45-degree field of view:
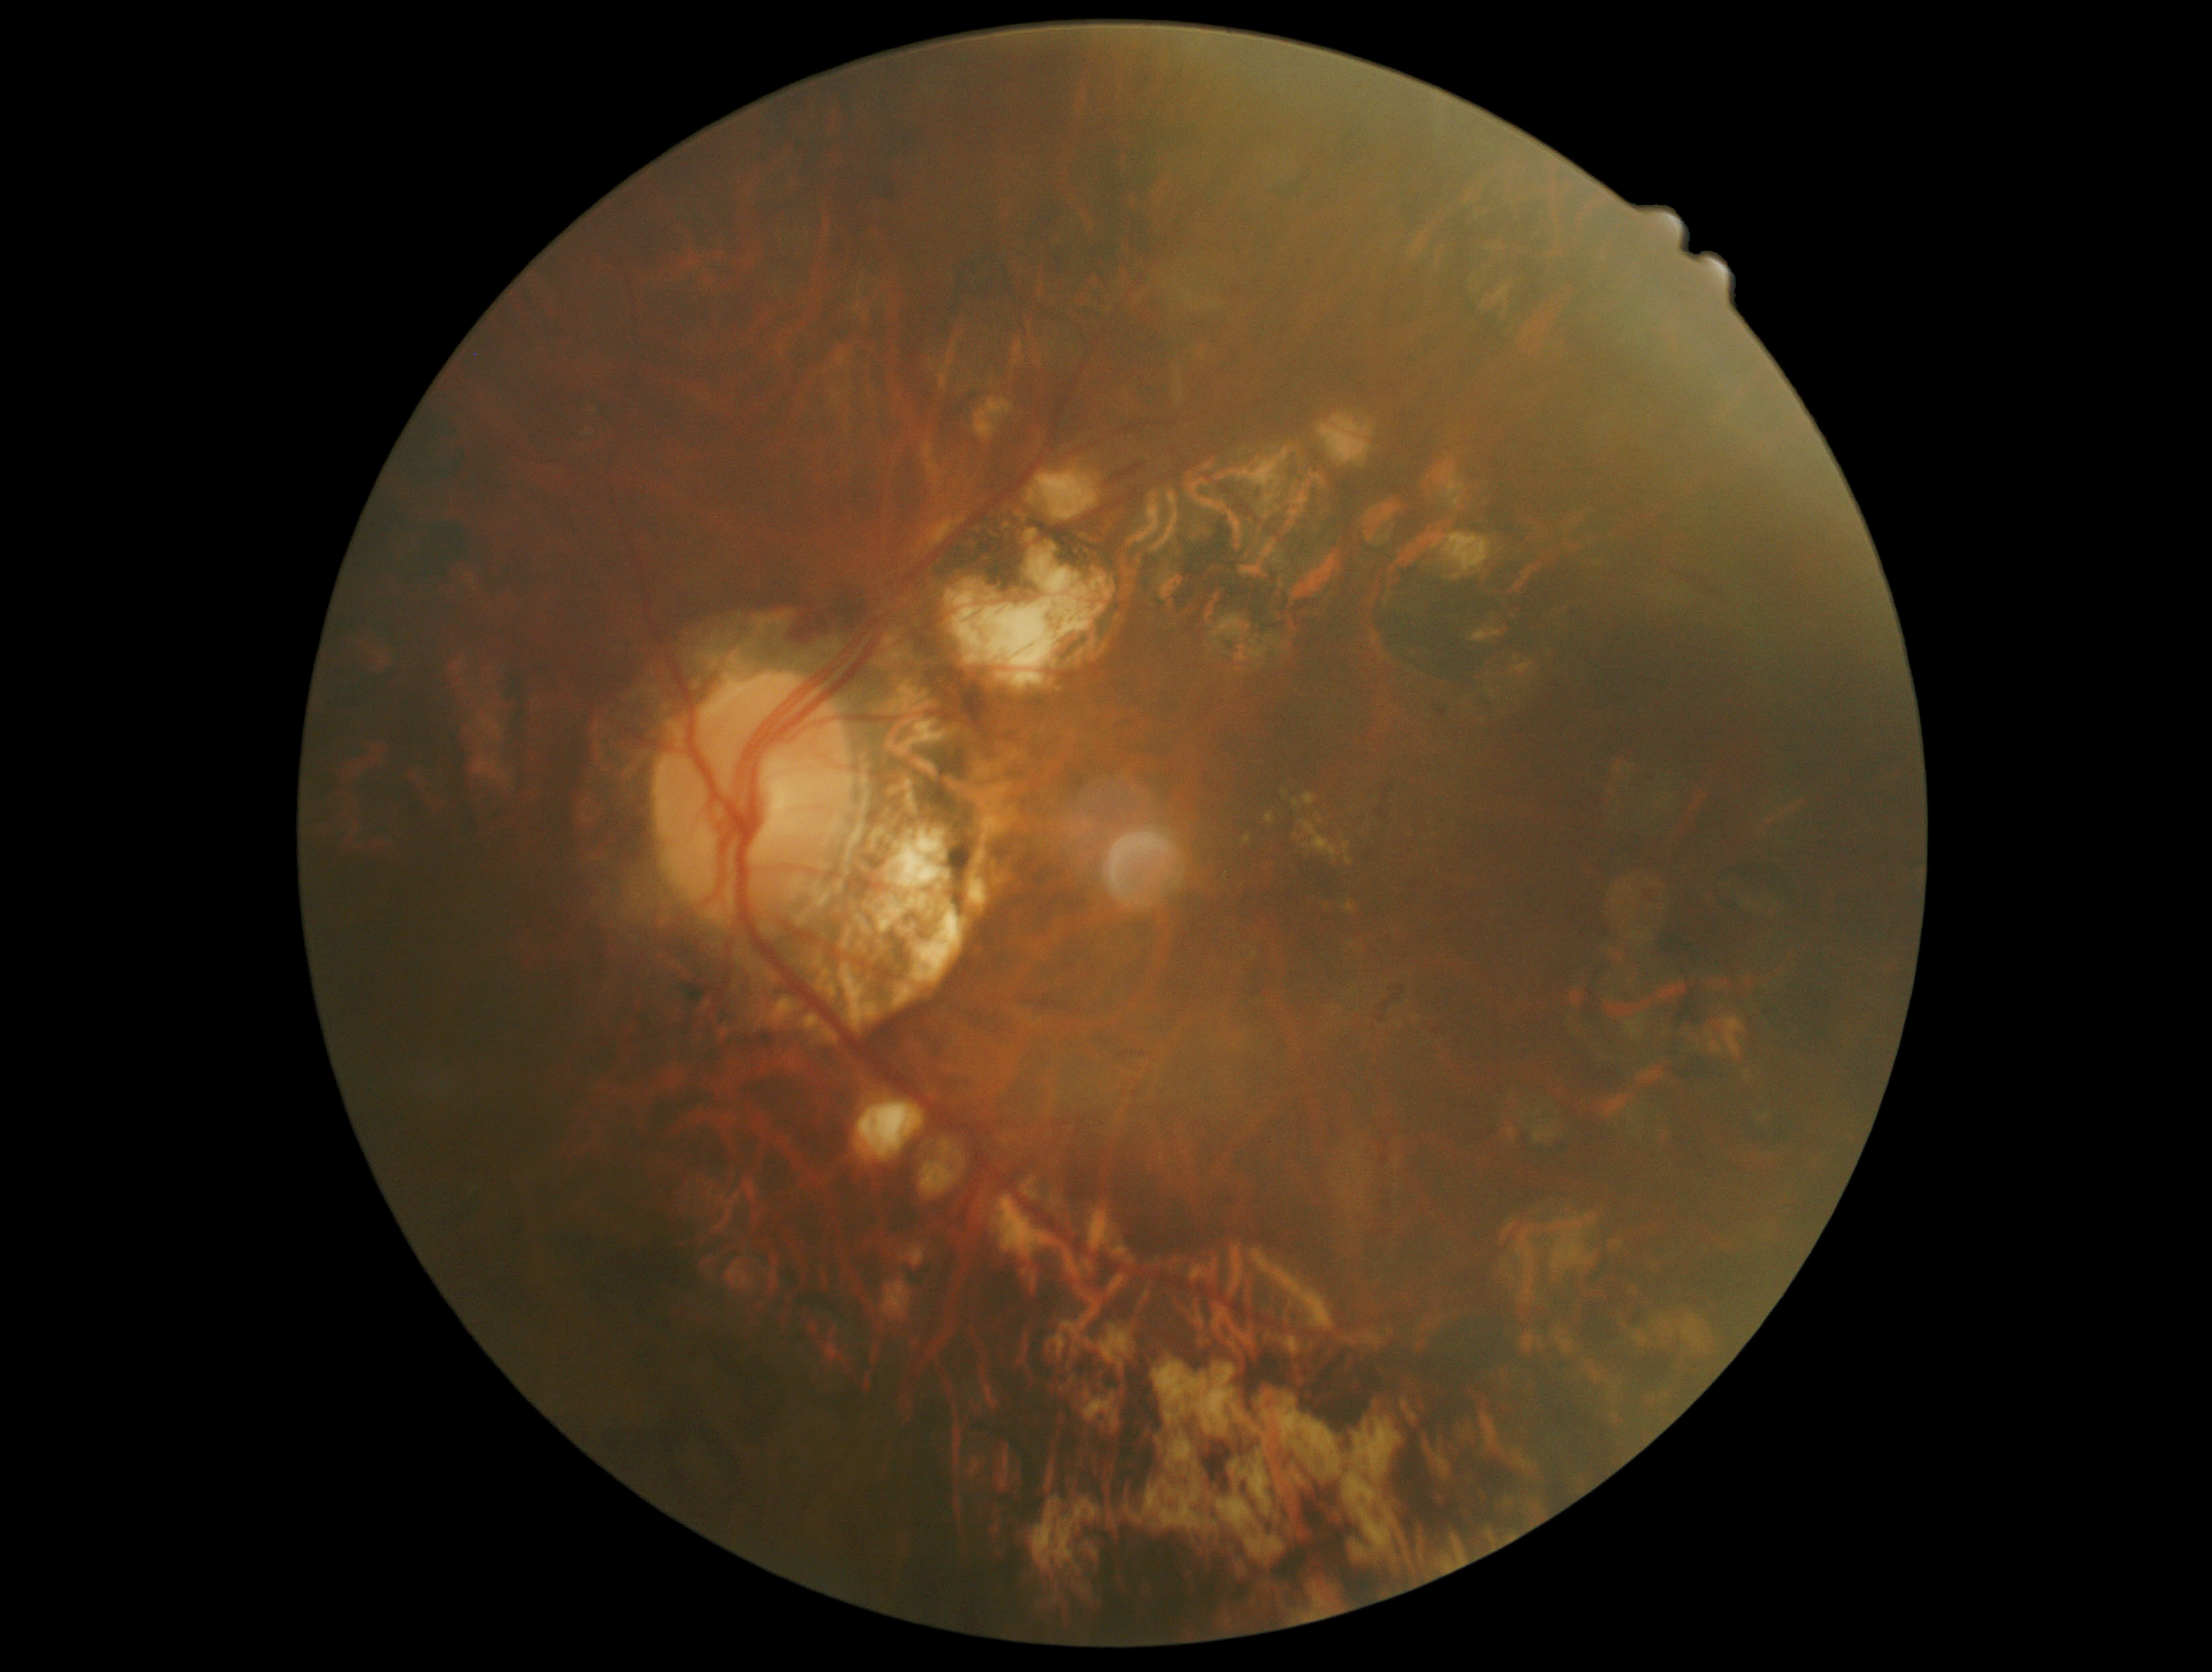

{
  "dr_grade": "2/4 — more than just microaneurysms but less than severe NPDR"
}